Retinal fundus photograph — 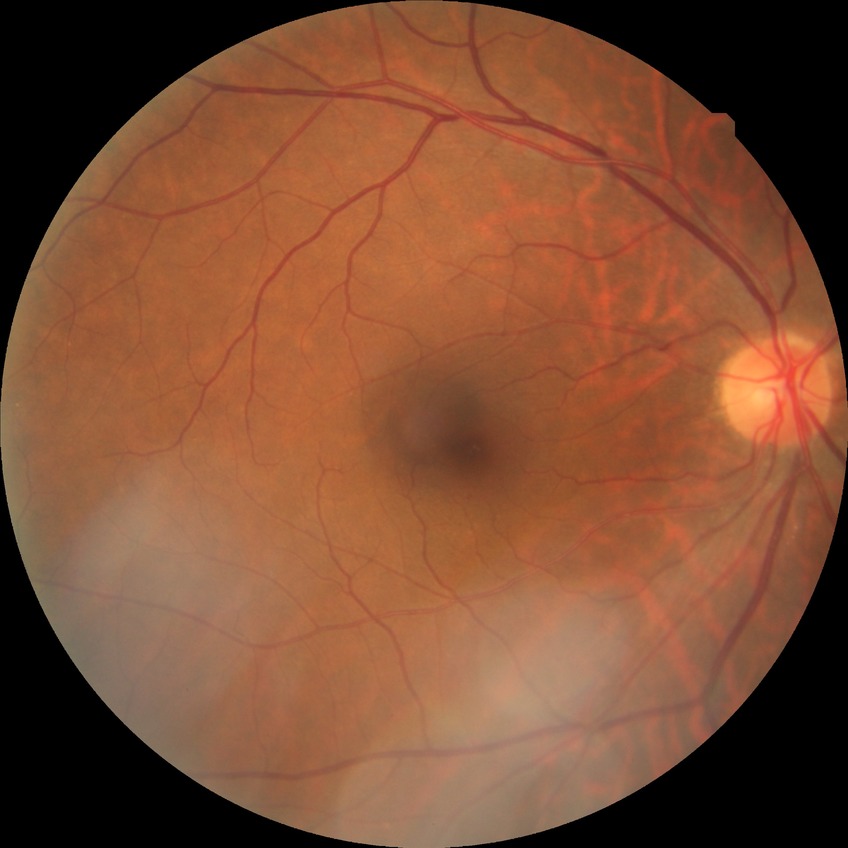 {
  "davis_grade": "NDR (no diabetic retinopathy)"
}